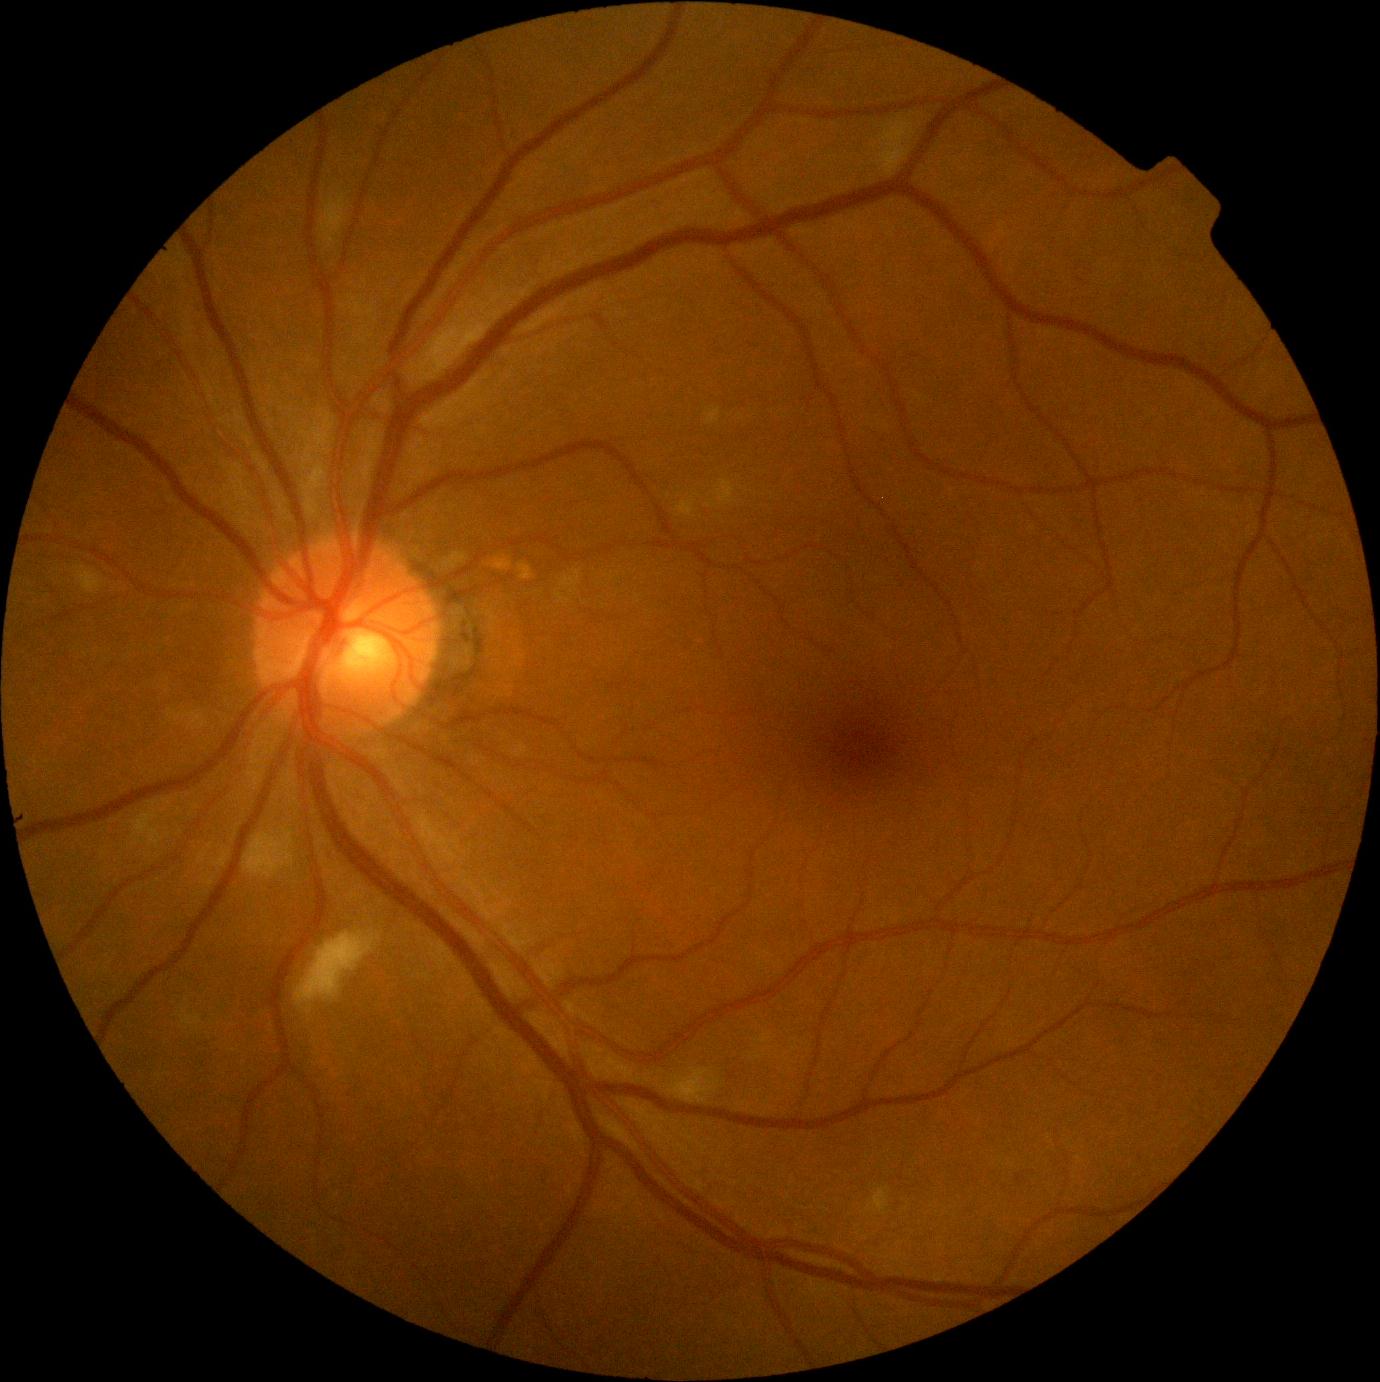

DR stage is moderate non-proliferative diabetic retinopathy (grade 2).